2352 x 1568 pixels:
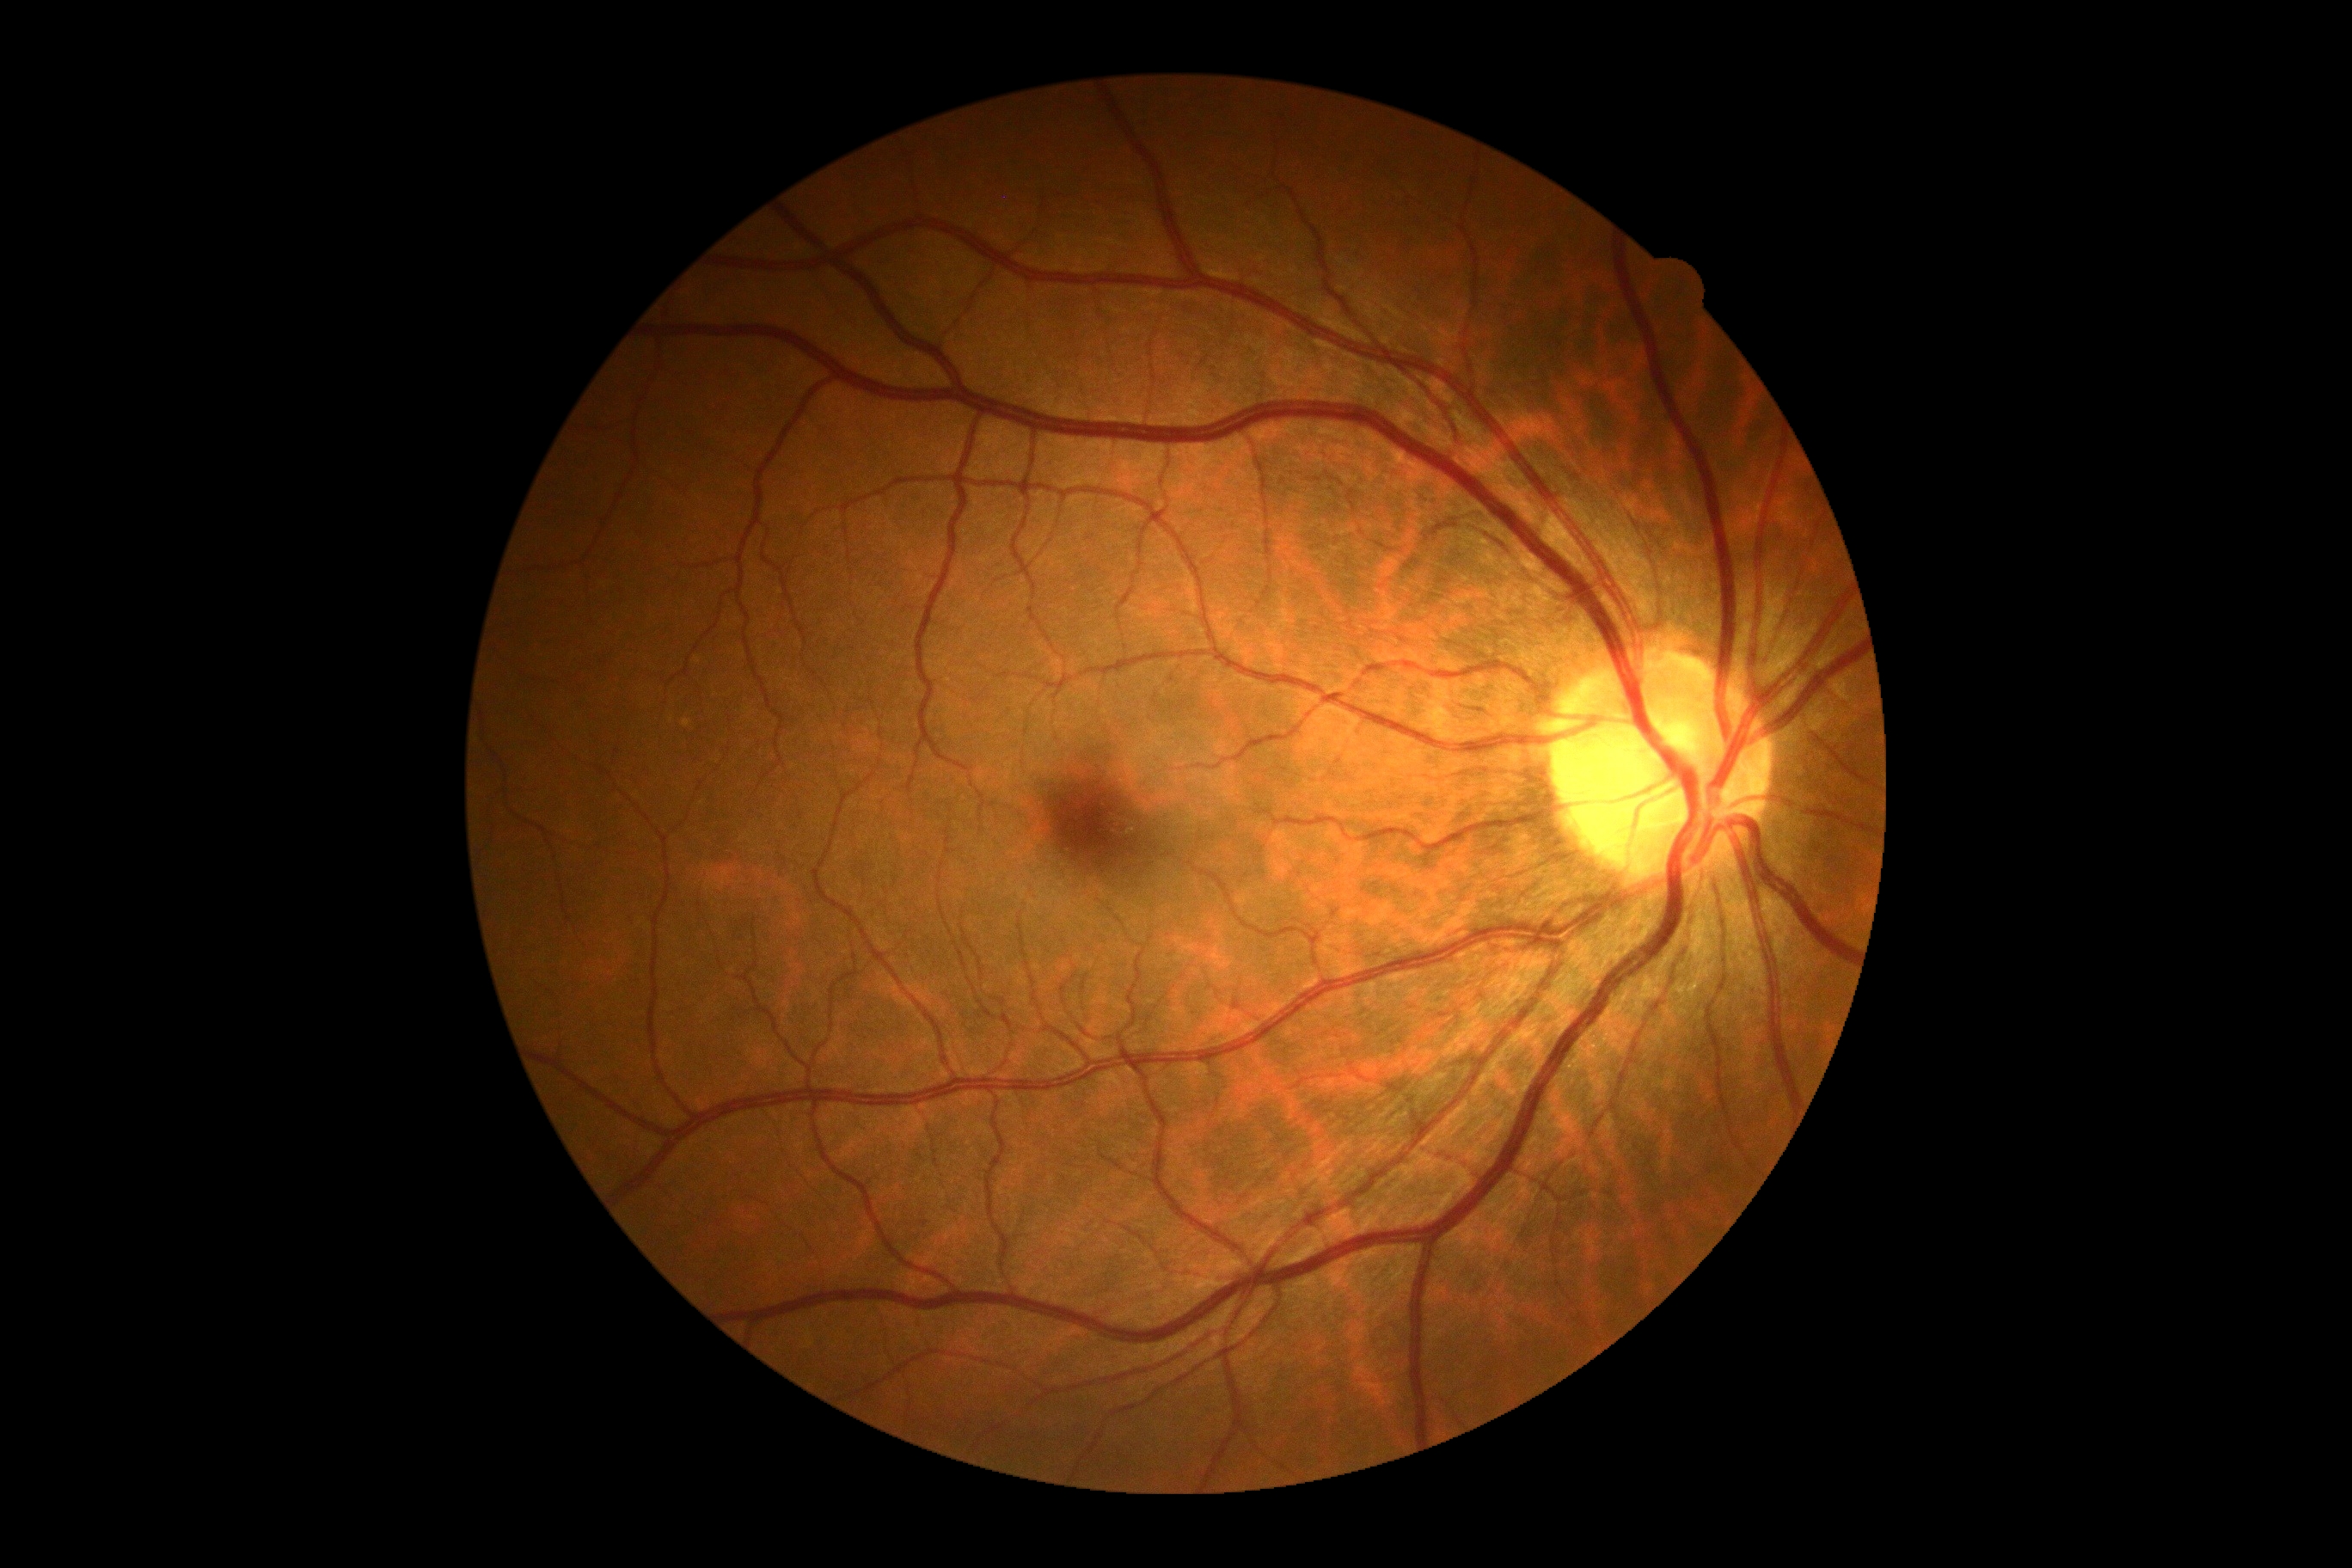
{"dr_grade": "grade 0 (no apparent retinopathy) — no visible signs of diabetic retinopathy", "dr_impression": "no DR findings"}